848 by 848 pixels, retinal fundus photograph, camera: NIDEK AFC-230, Davis DR grading, 45° field of view — 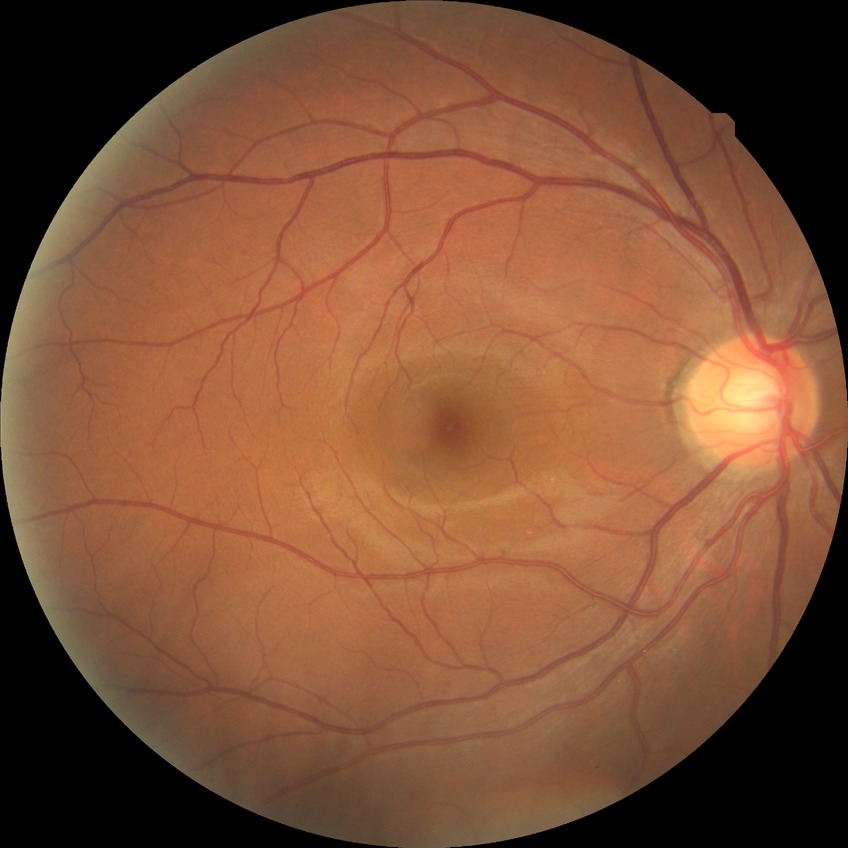

Assessment:
* Davis grading: no diabetic retinopathy